2352 by 1568 pixels.
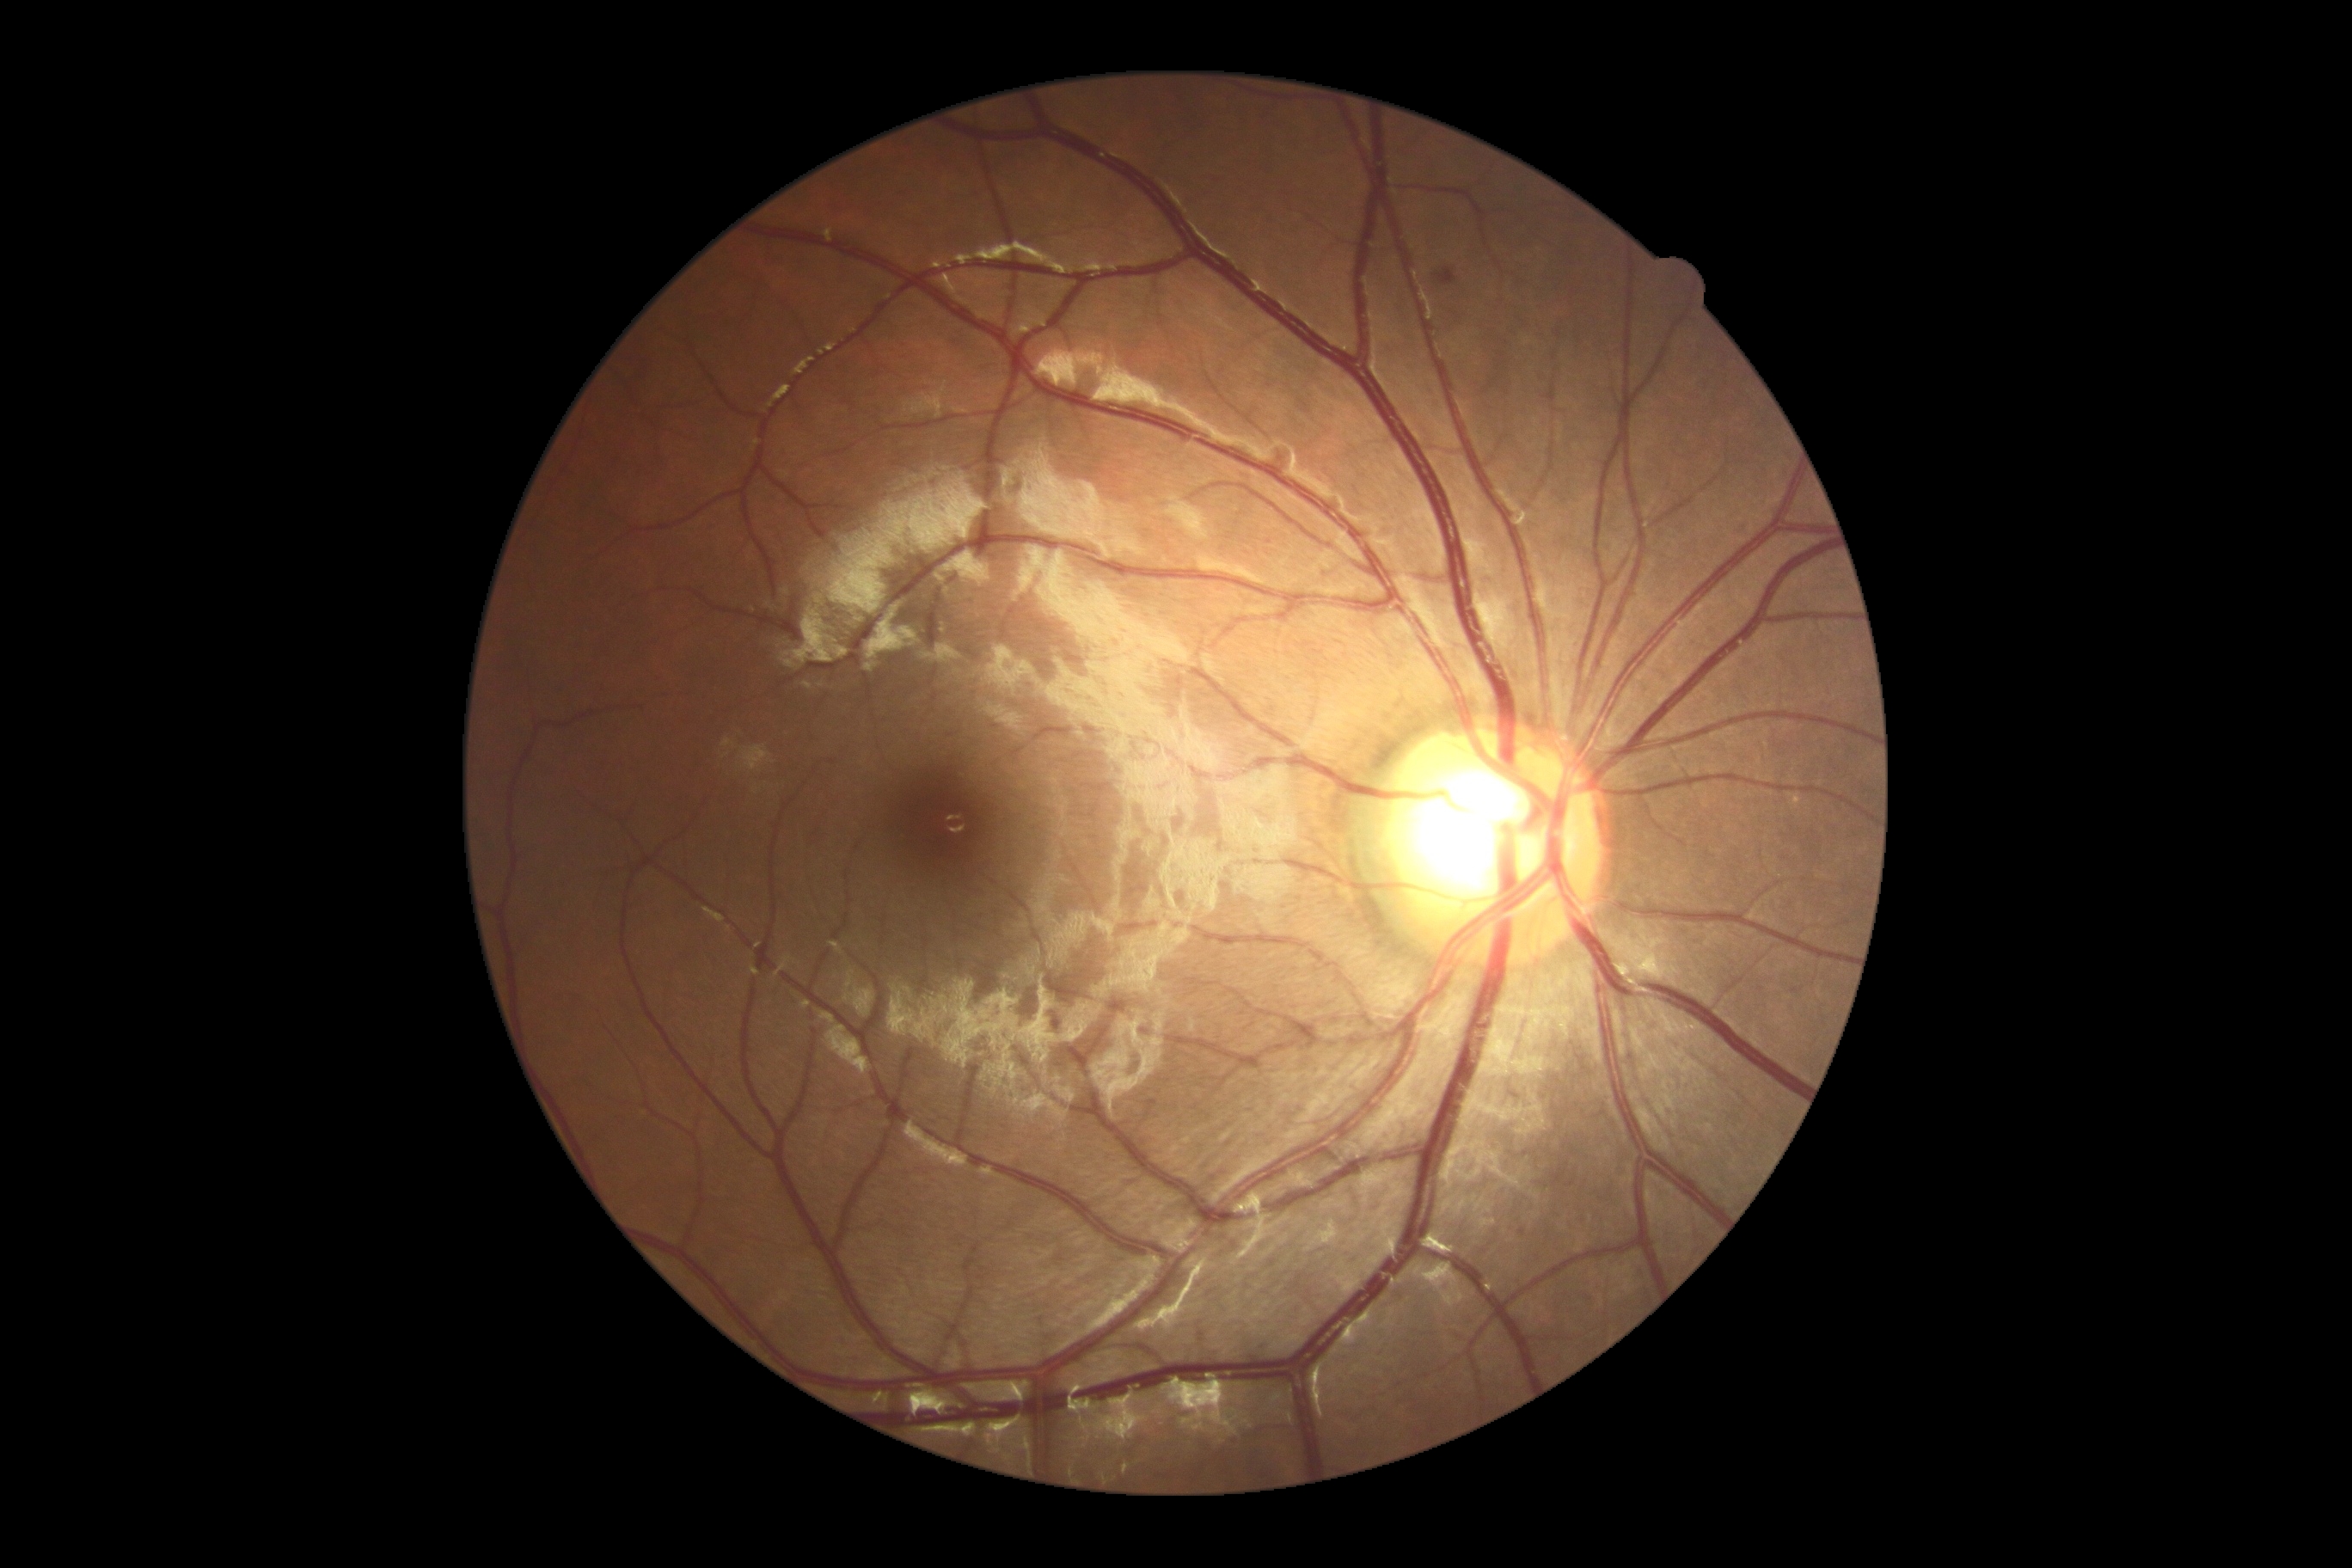 DR severity@grade 2 (moderate NPDR).